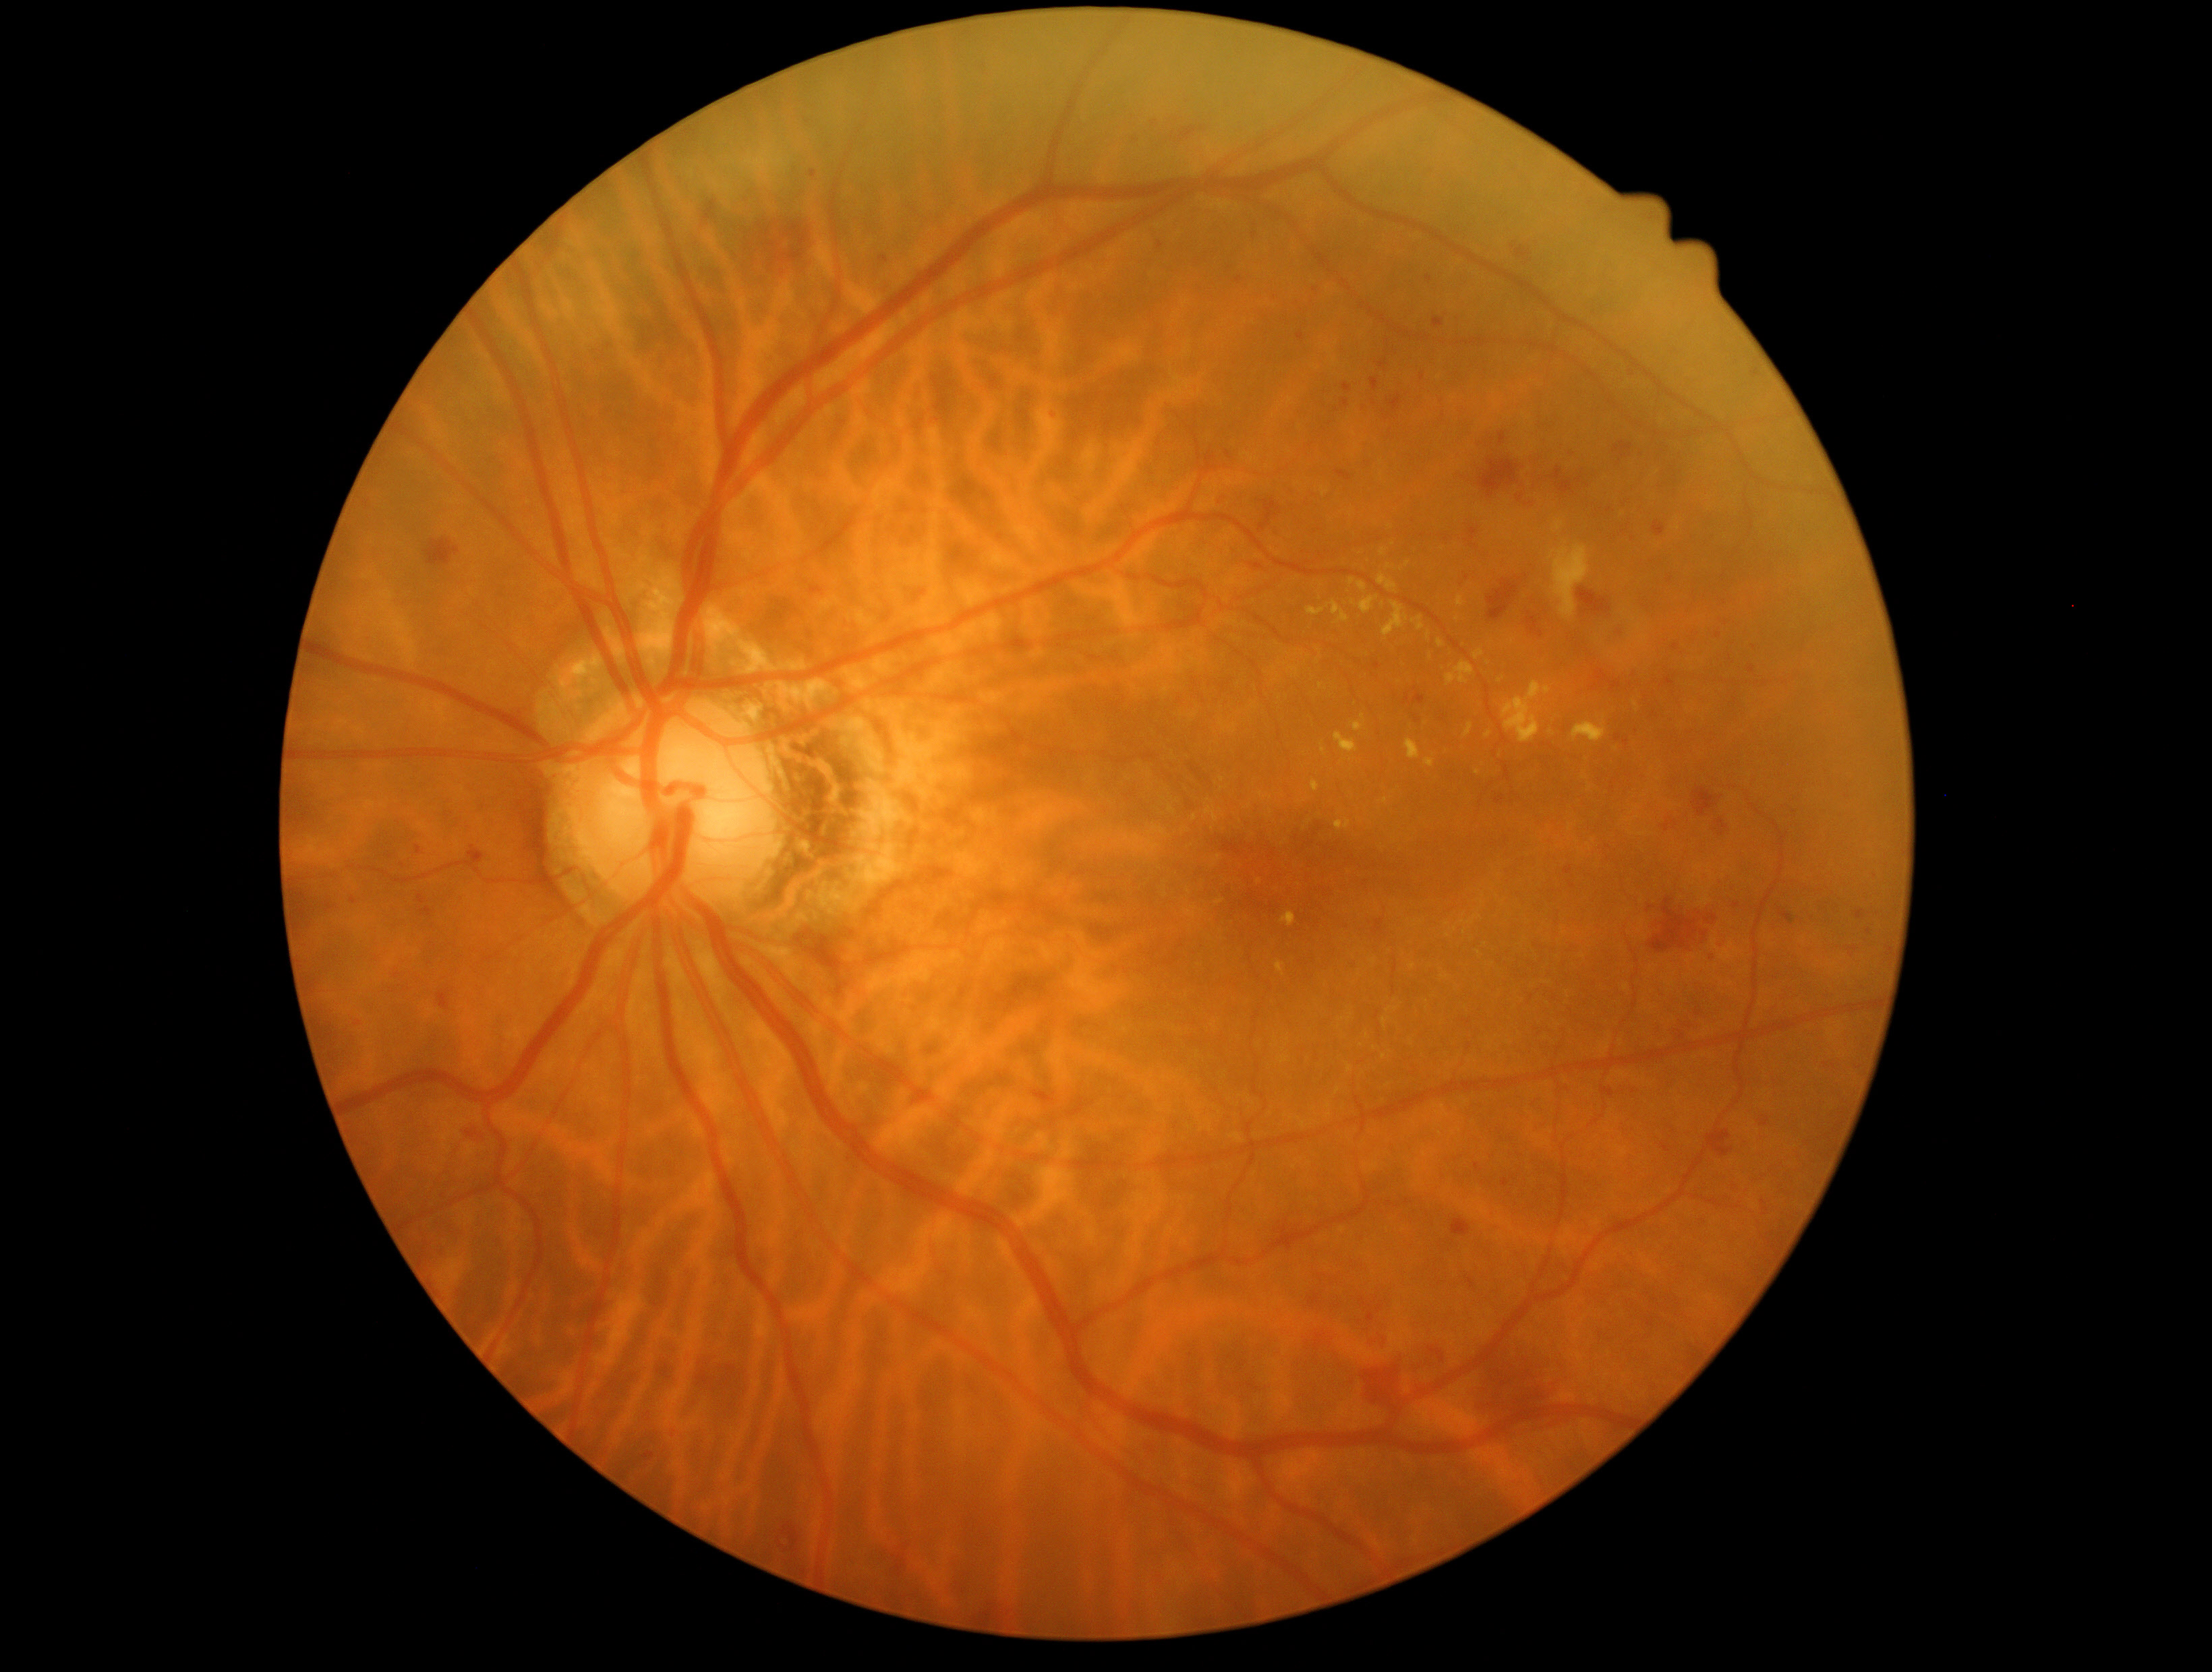

<lesions partial="true">
  <dr_grade>2</dr_grade>
  <ex partial="true">1335,733,1358,754; 1436,1106,1445,1110; 1306,607,1325,617; 1169,807,1175,815; 1457,595,1465,607; 1503,682,1552,744; 1633,702,1639,713; 1406,740,1420,761; 1348,1065,1352,1073; 1312,780,1321,792</ex>
  <ex_small_approx>(1363,717); (1260,881); (1412,966); (1616,750); (1478,773); (1570,828); (1408,565)</ex_small_approx>
  <he partial="true">1368,918,1385,936; 389,966,401,980; 1664,1144,1670,1152; 426,539,461,568; 1591,669,1622,692; 1467,1276,1475,1288; 903,586,926,607; 1374,663,1382,671; 1291,296,1306,314; 1635,877,1755,961; 1751,370,1762,378; 1341,1259,1367,1274; 420,908,434,918; 1882,946,1893,965</he>
  <he_small_approx>(1626,743); (432,944); (1869,932); (1670,580)</he_small_approx>
</lesions>